Retinal fundus photograph · image size 2352x1568 · 45° field of view: 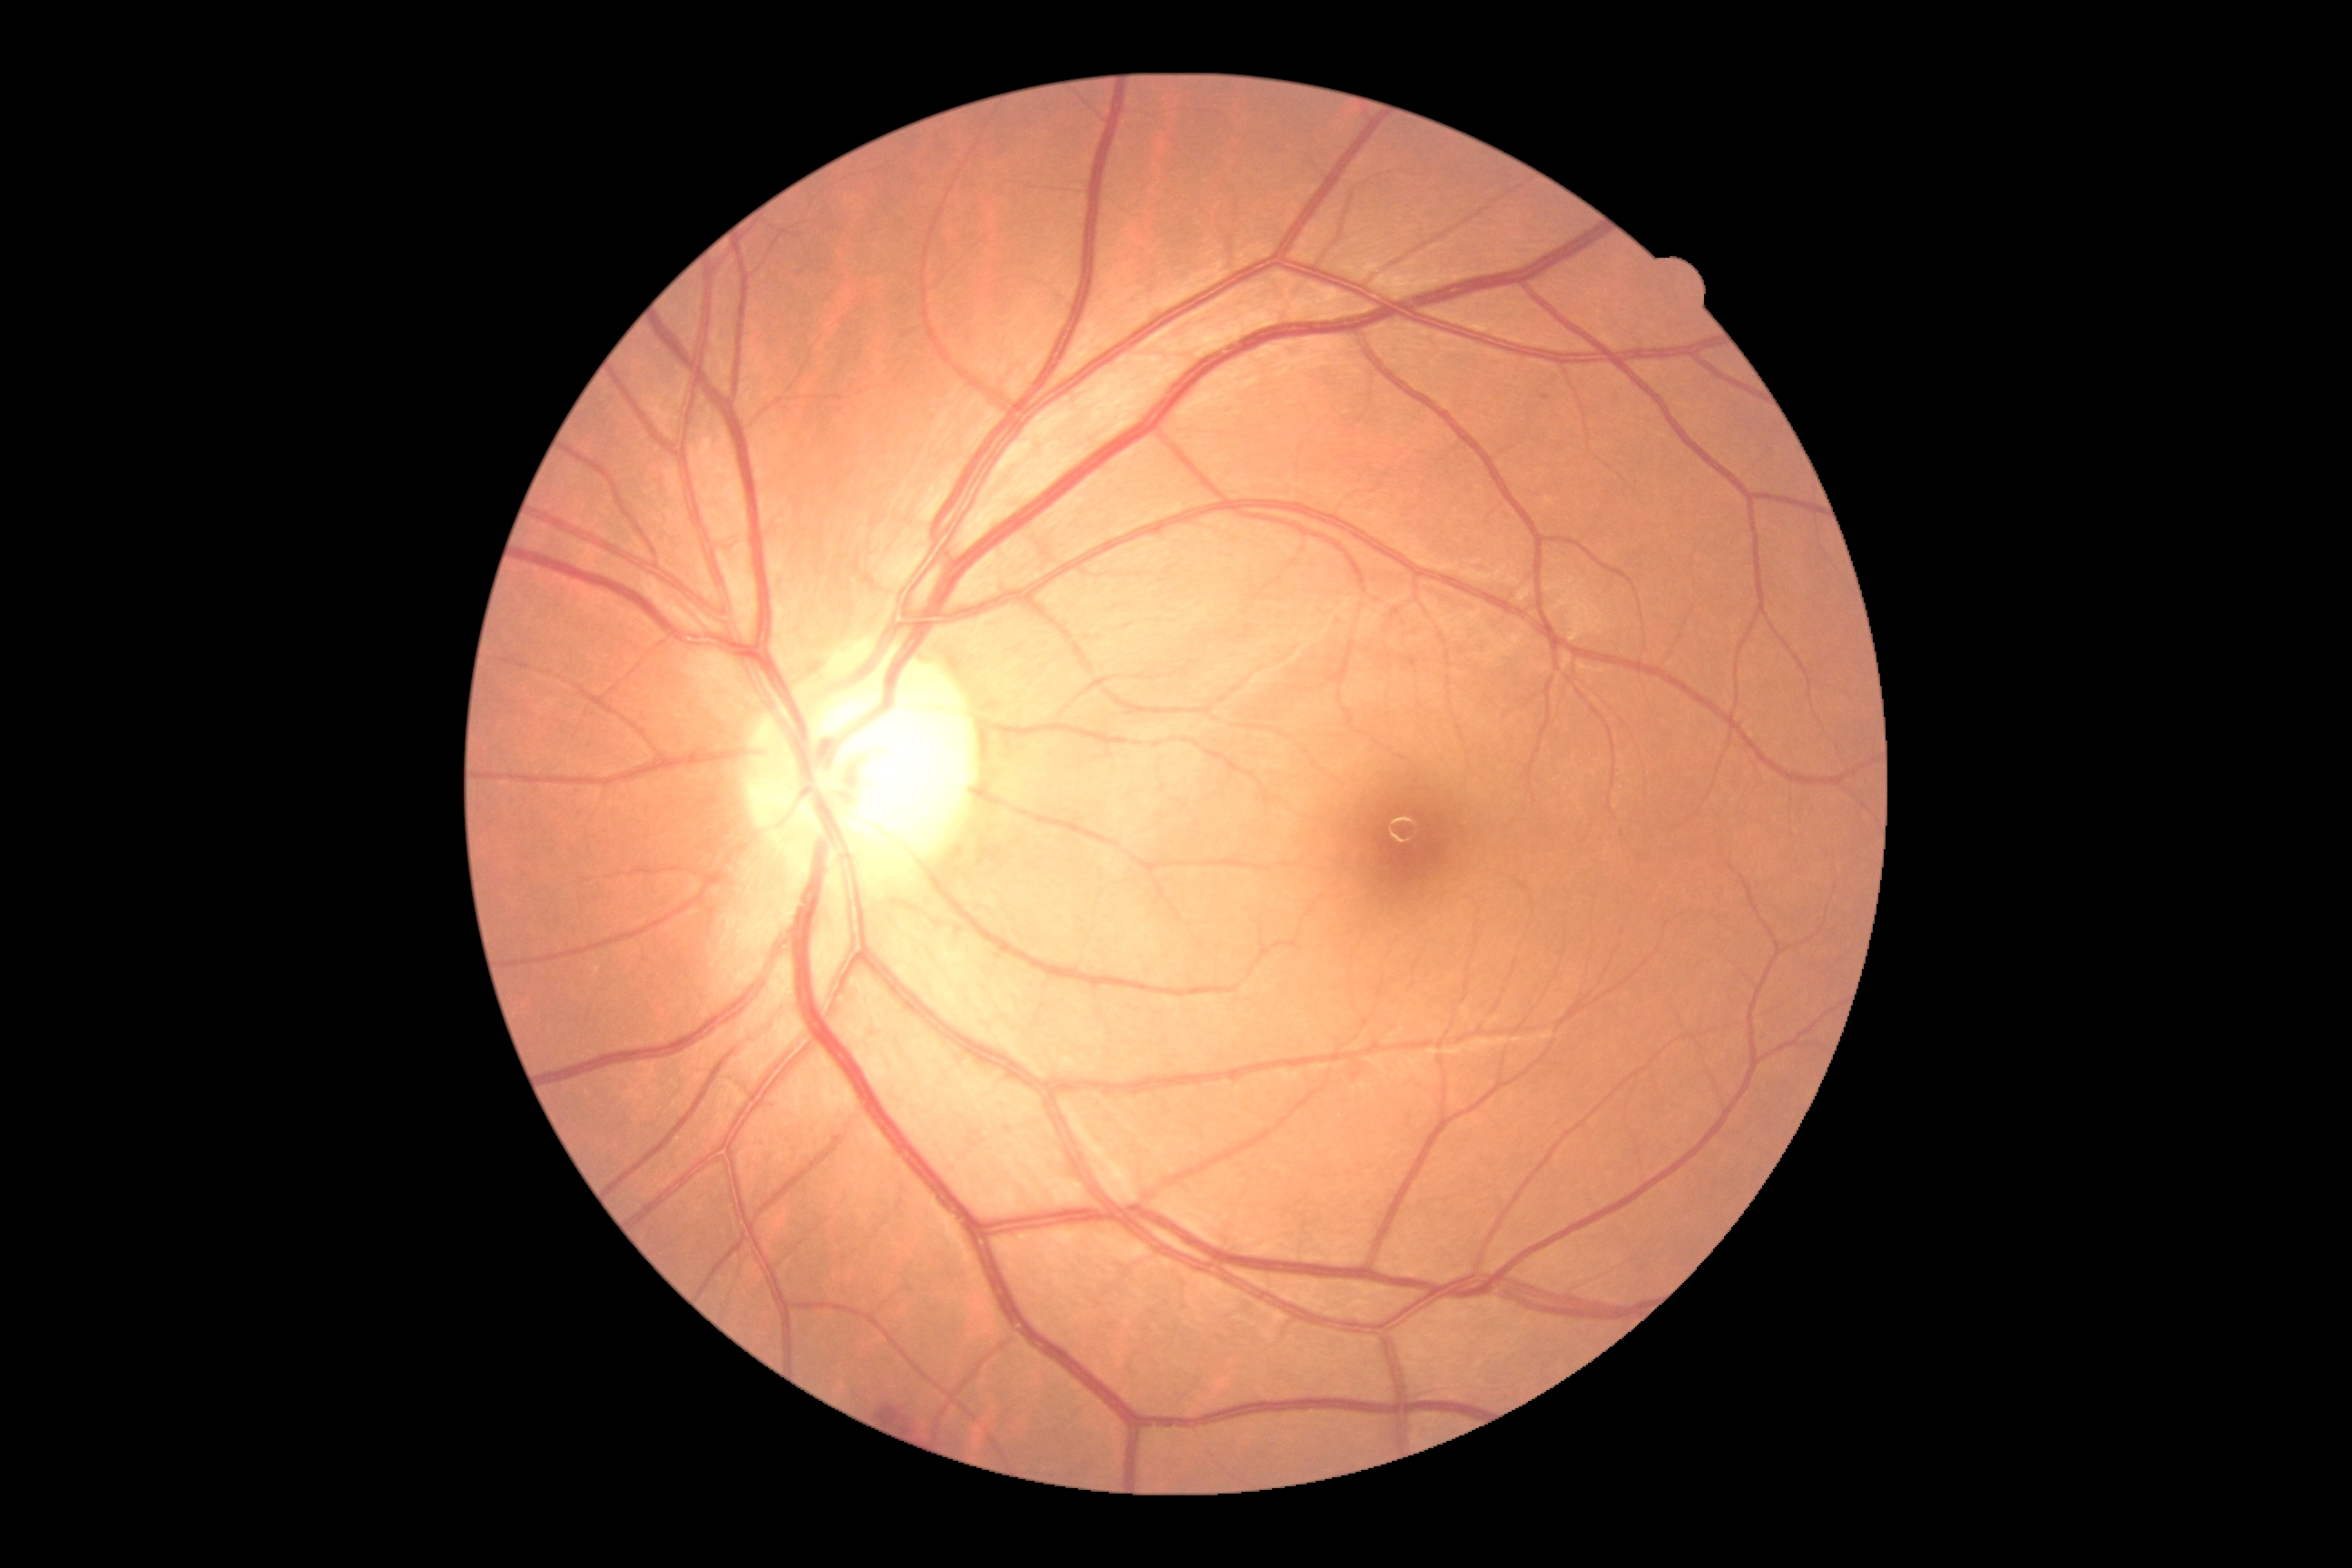
Retinopathy grade: moderate non-proliferative diabetic retinopathy (2).